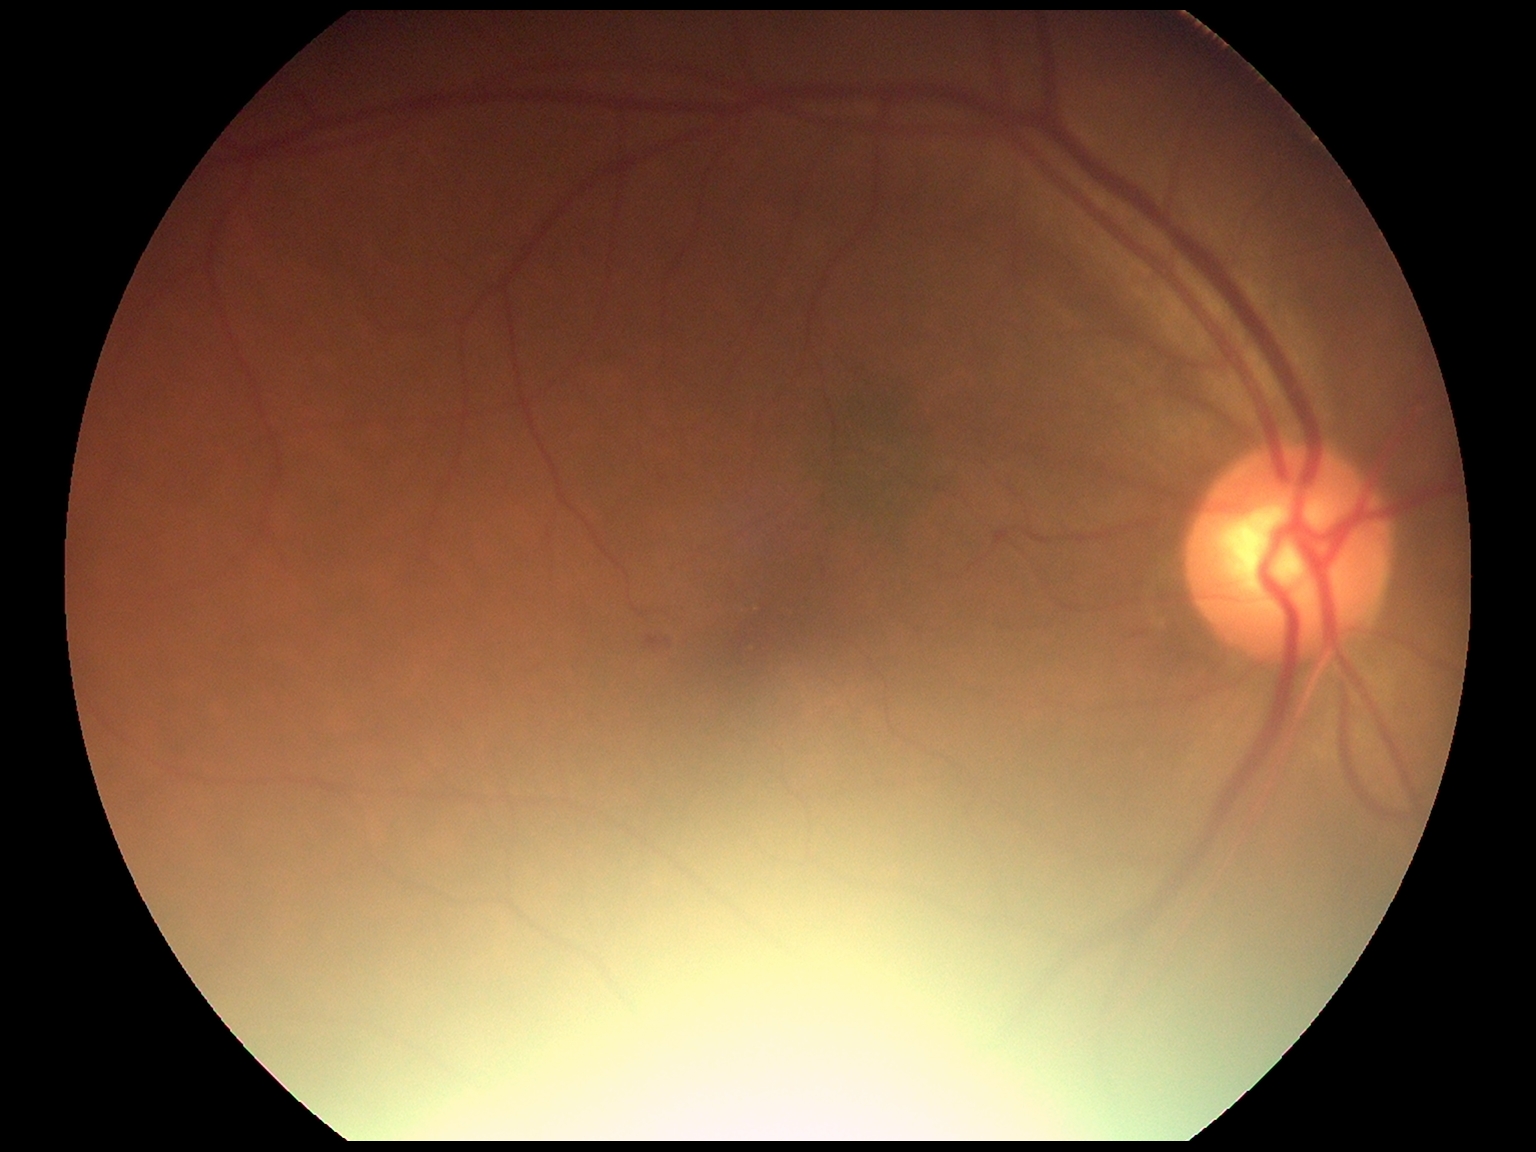
Diabetic retinopathy severity: grade 2 (moderate NPDR) — more than just microaneurysms but less than severe NPDR.